Retinal fundus photograph.
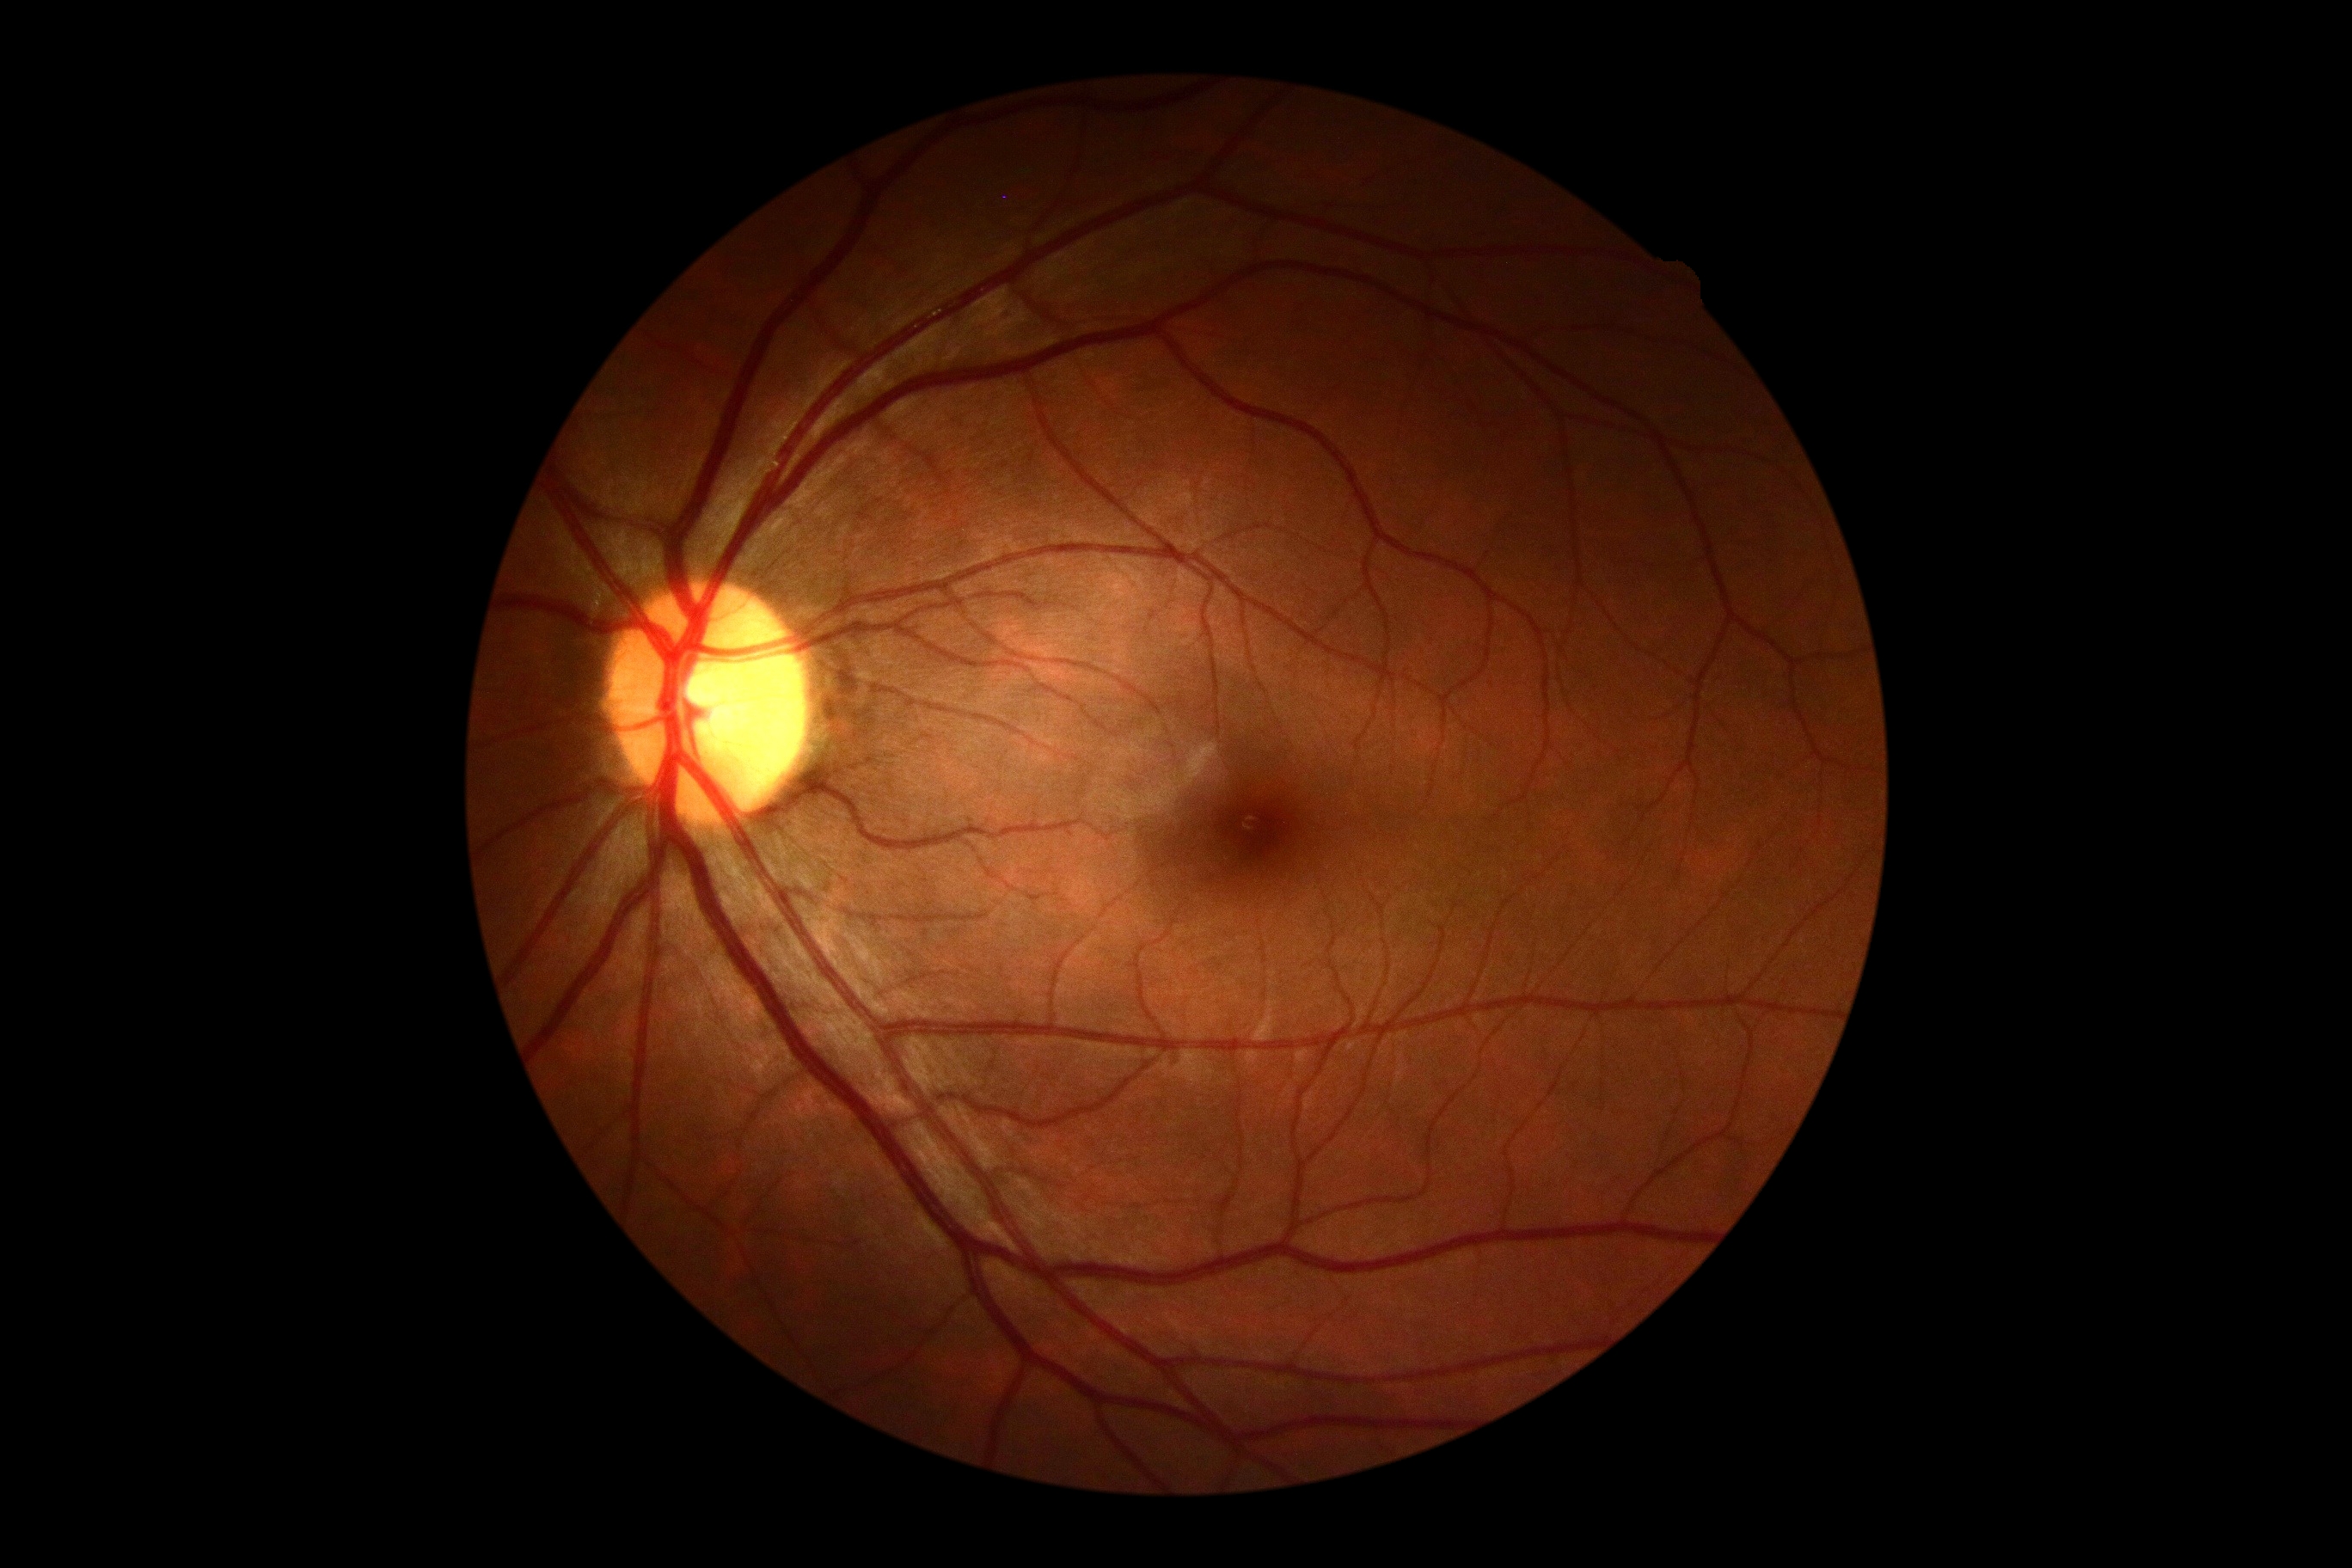 Retinopathy is no apparent diabetic retinopathy (grade 0).